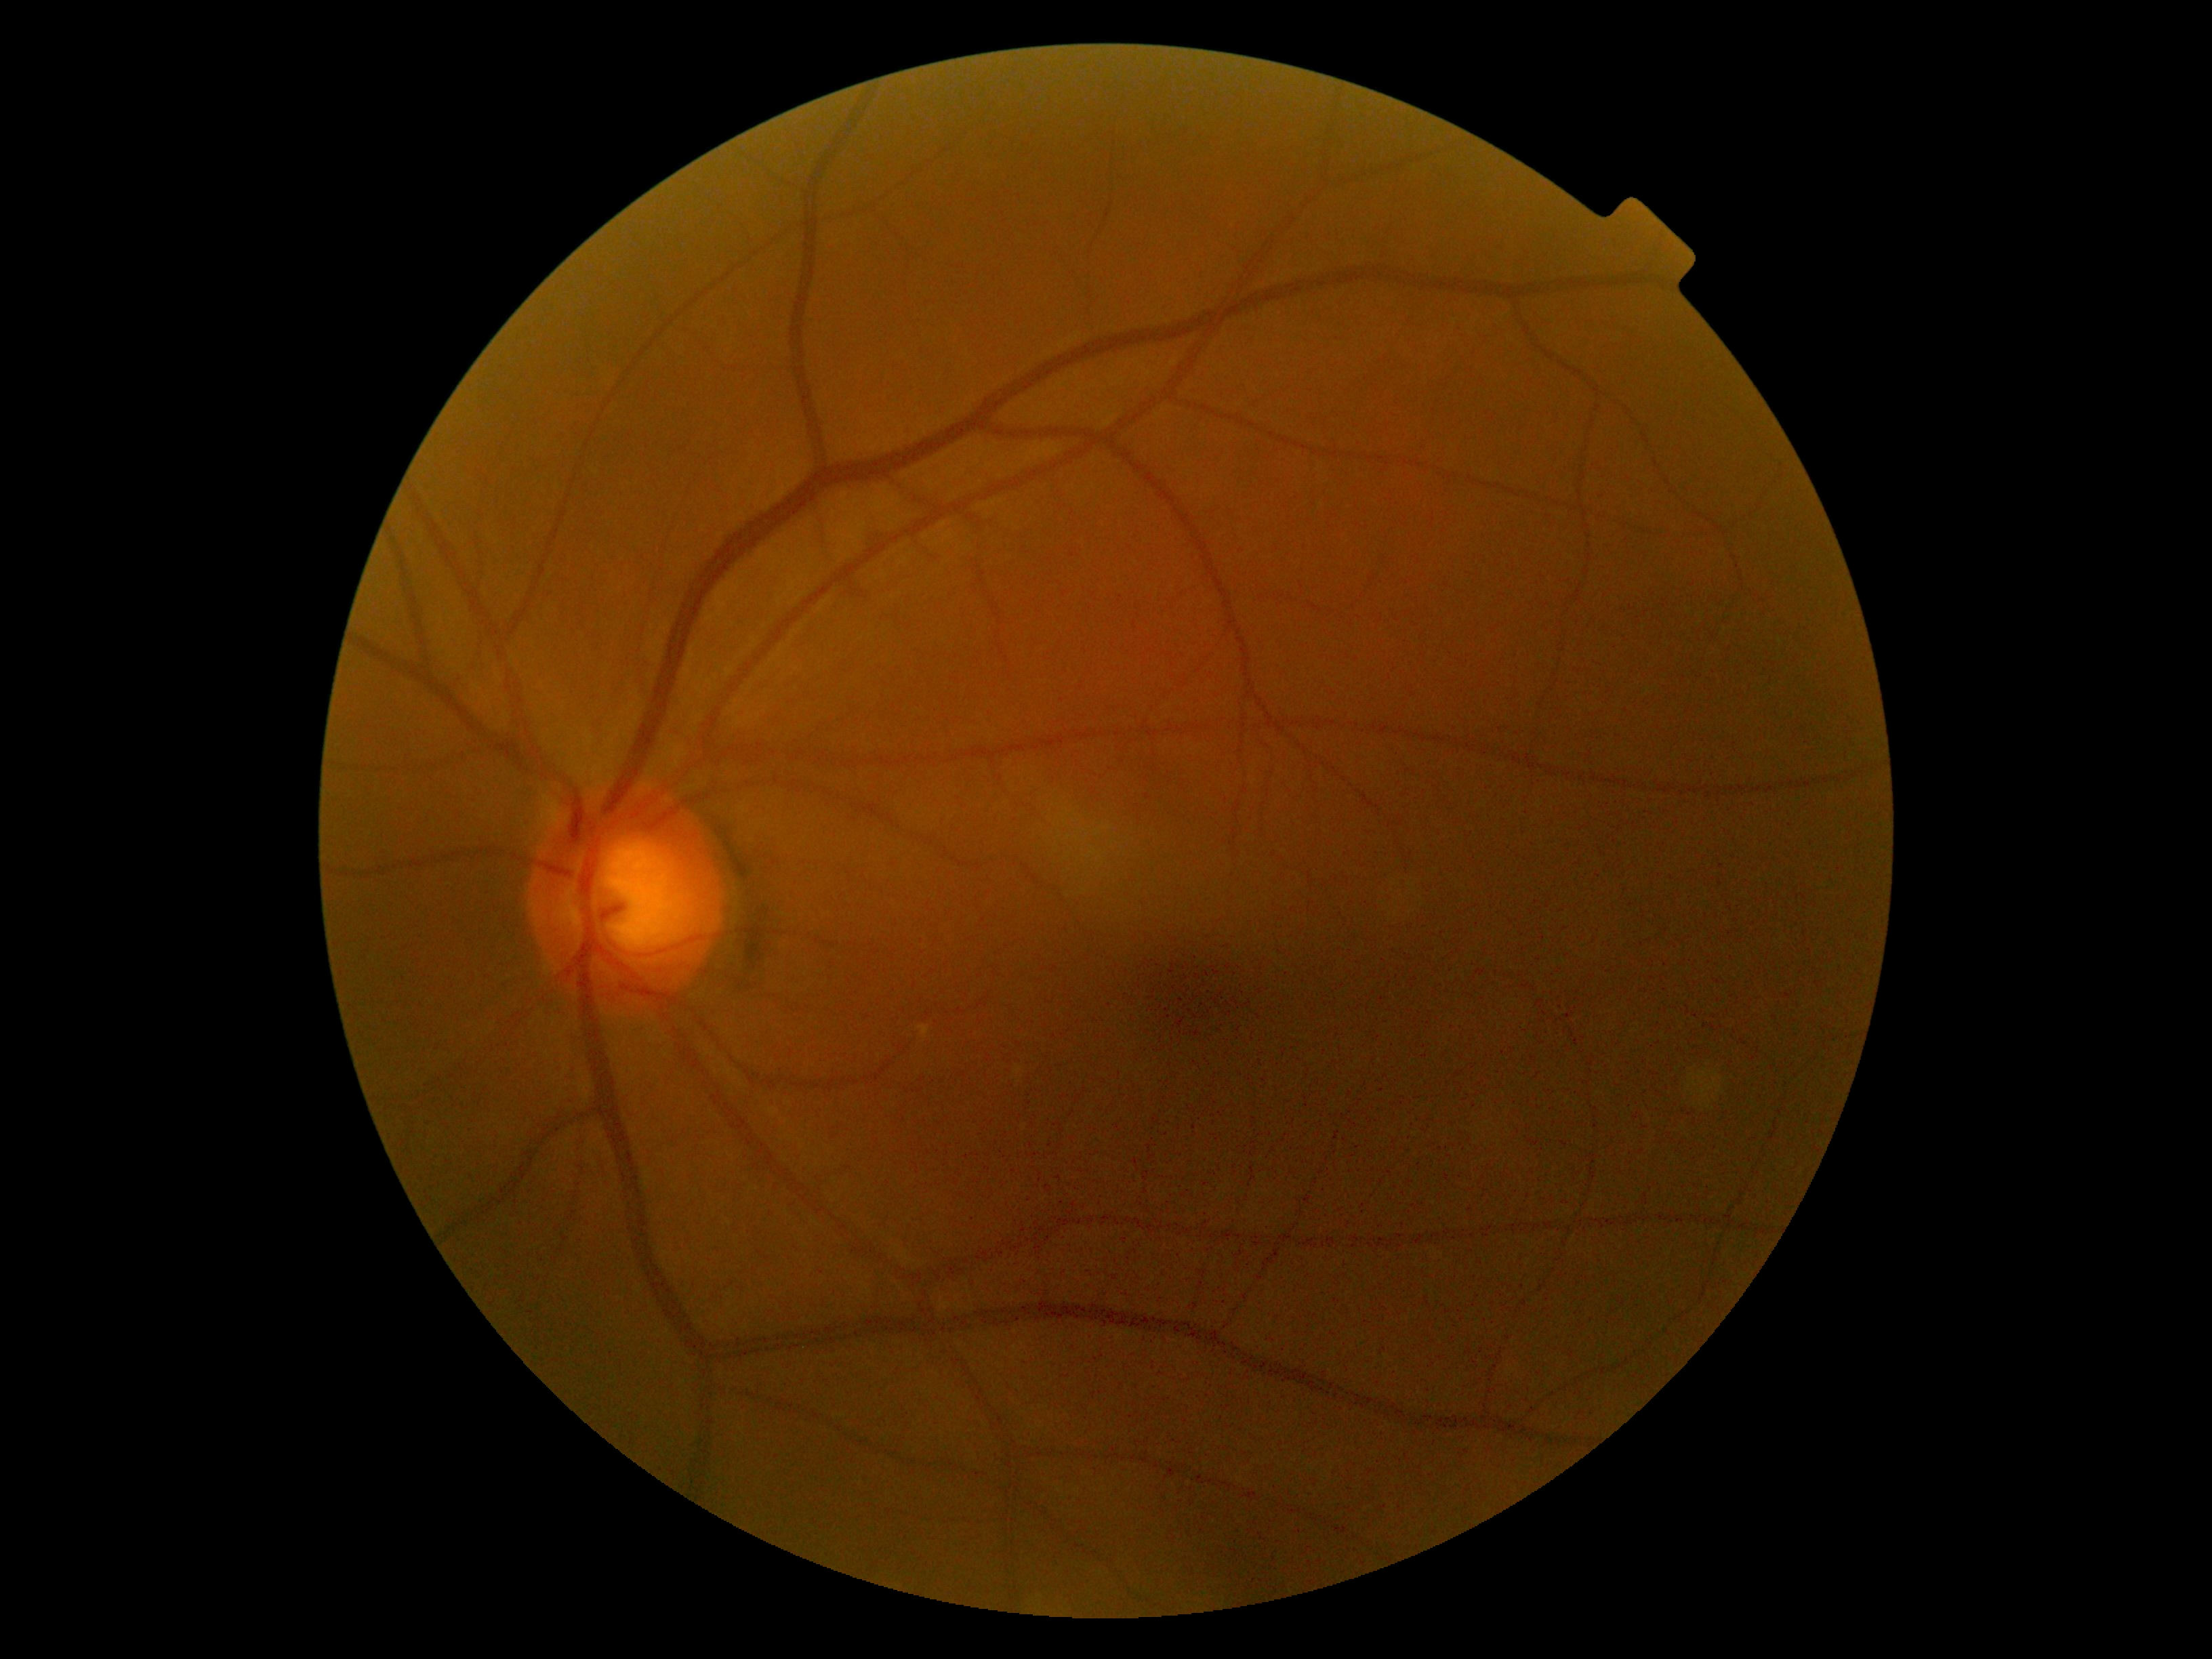

DR impression=no DR findings; DR severity=no apparent retinopathy (grade 0).